Wide-field fundus image from infant ROP screening:
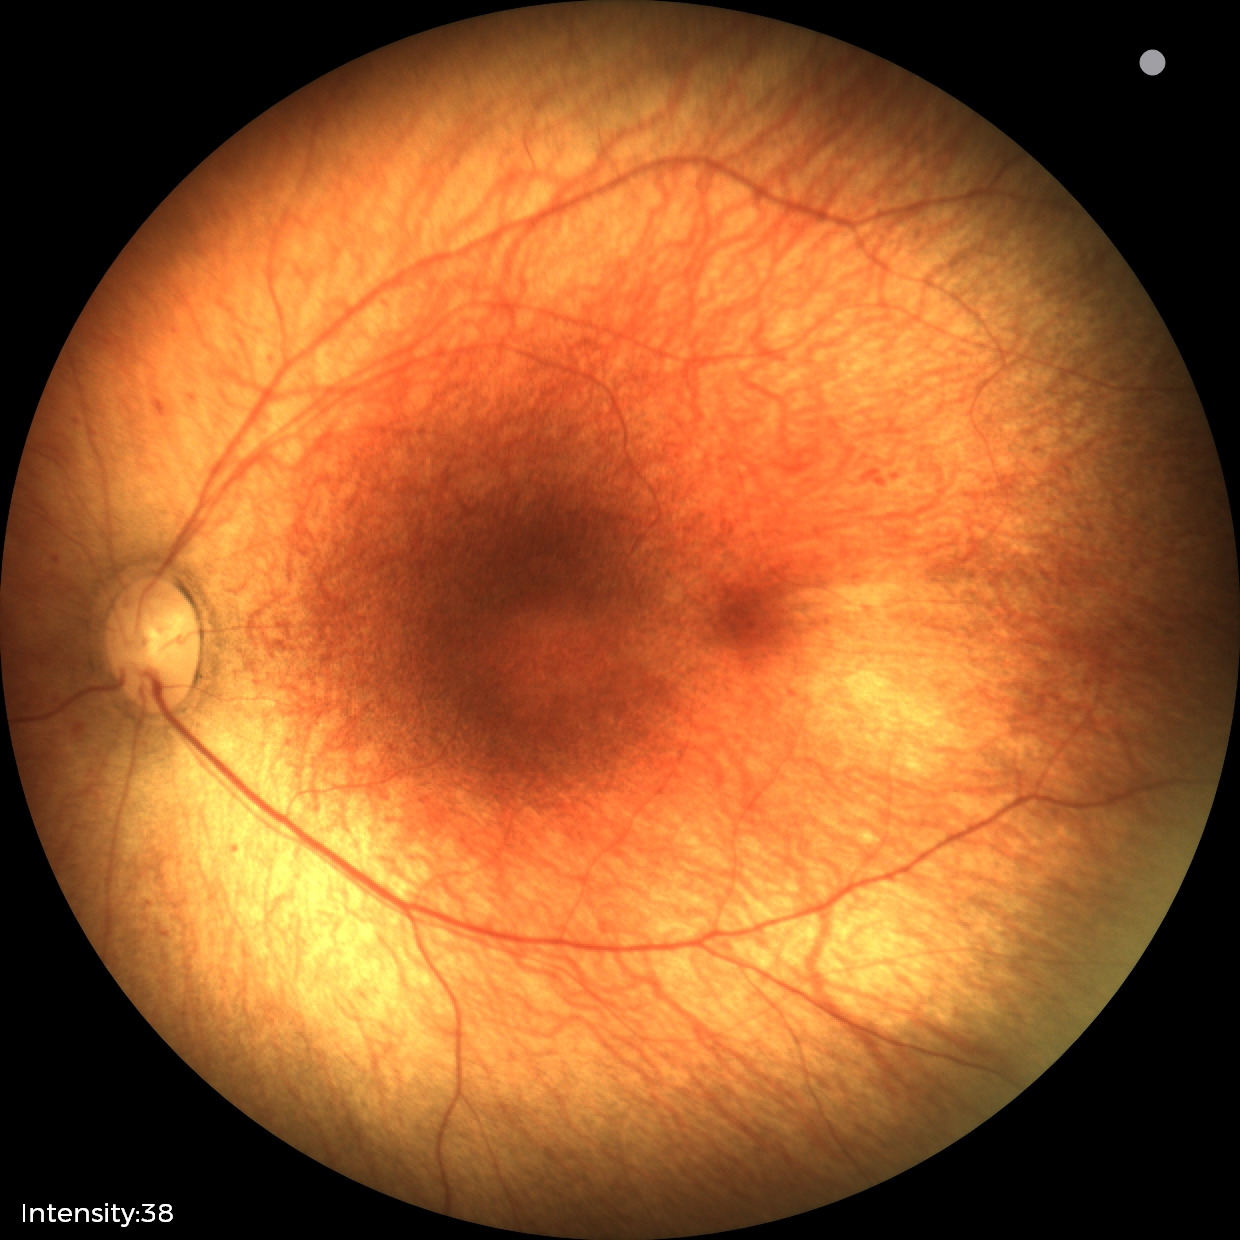
Assessment: no abnormal retinal findings.